Phoenix ICON wide-field infant fundus image · camera: Phoenix ICON (100° FOV) · image size 1240x1240
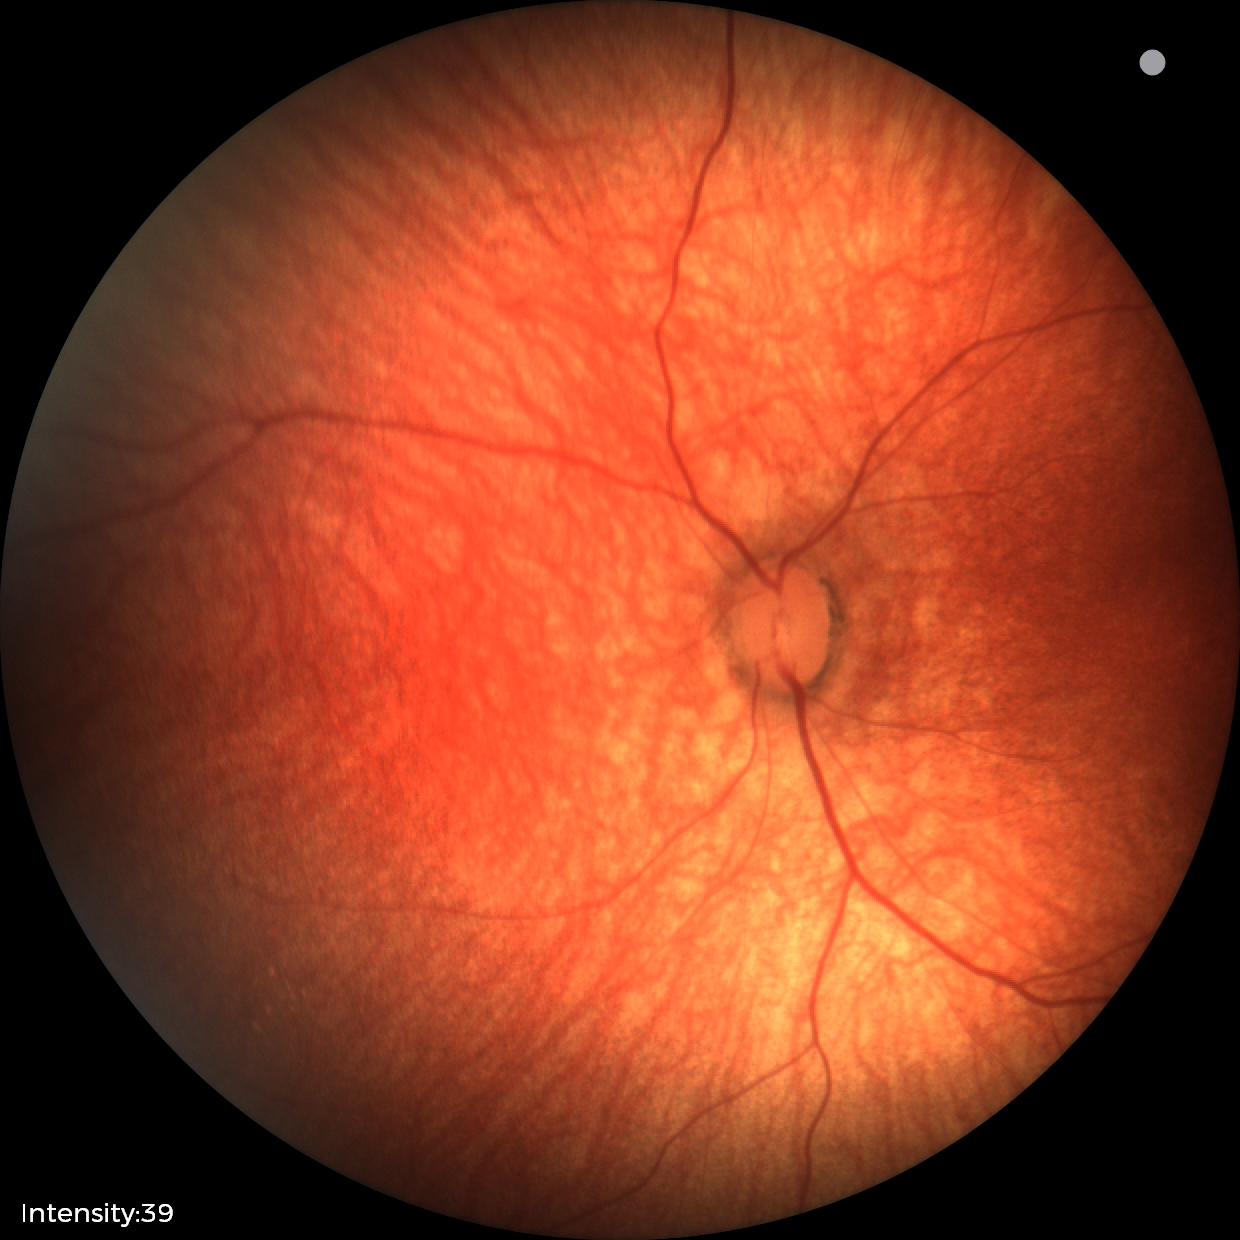
Diagnosis = normal.